Central corneal thickness 482 µm. Captured on a Topcon TRC-NW400 fundus camera. Centered on the optic disc. 2212 x 1661 pixels. Color fundus image. FOV: 30 degrees. Undilated pupil:
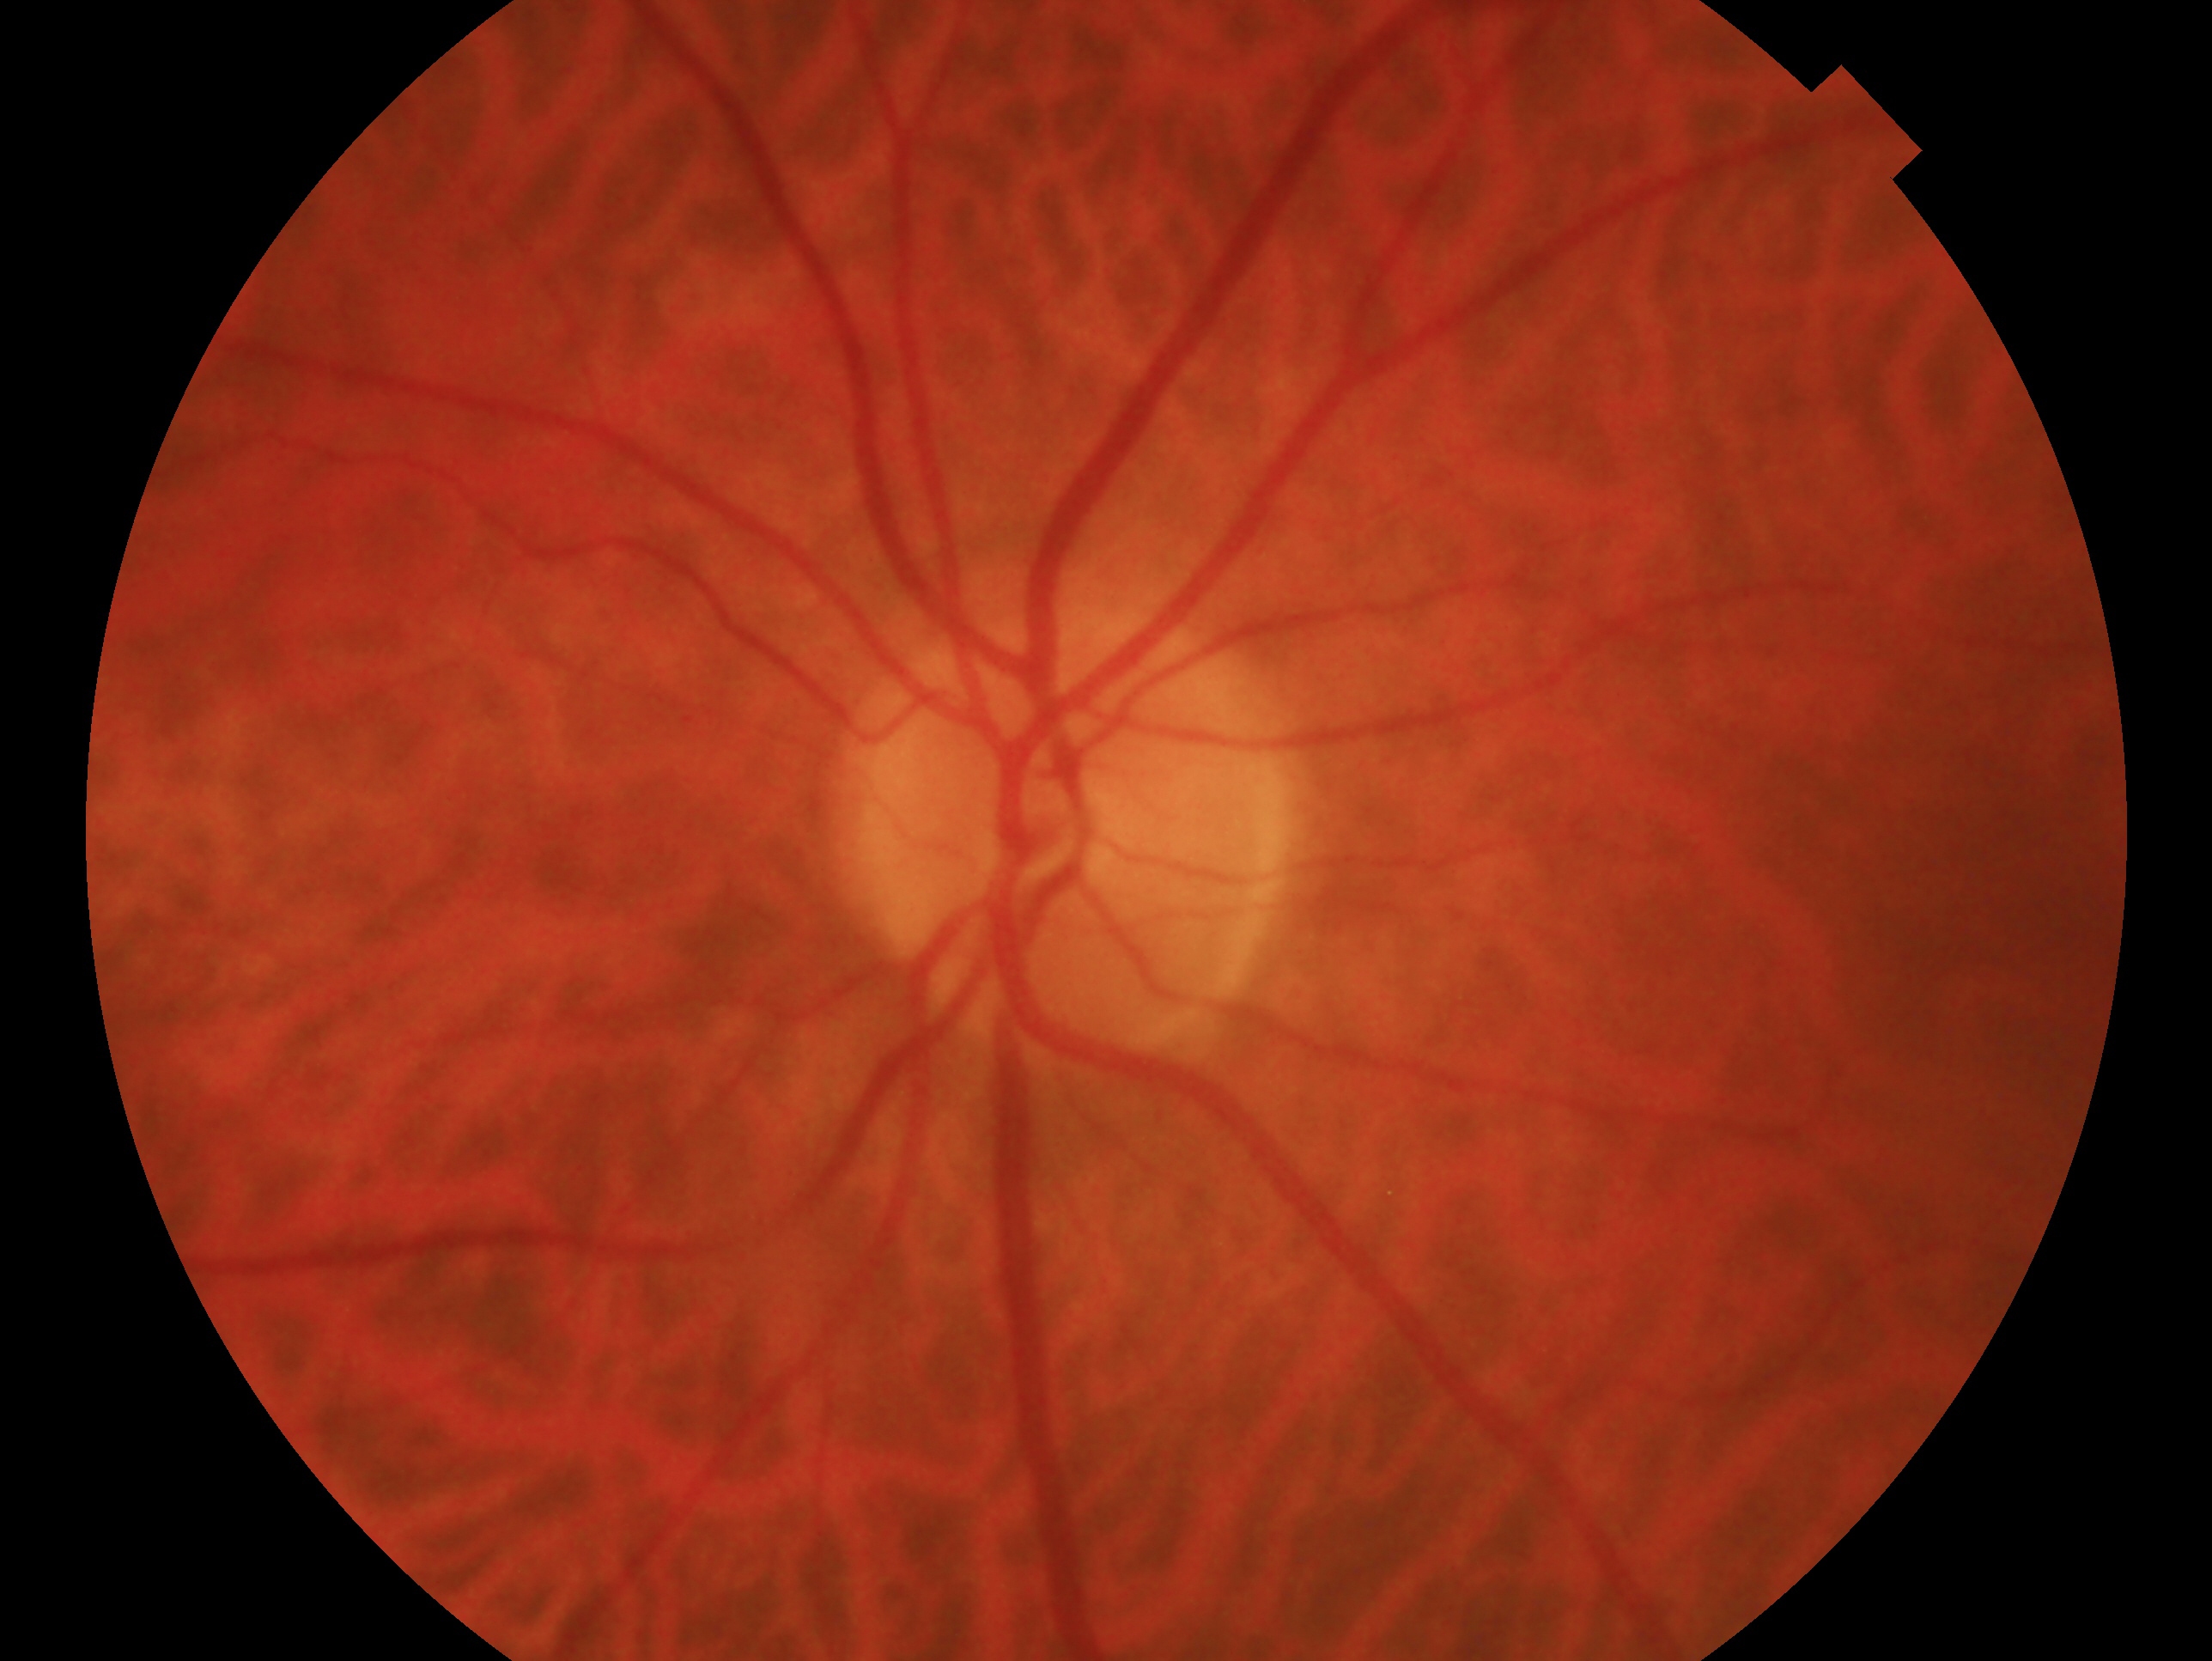

Glaucoma assessment — negative for glaucoma. Eye: oculus sinister.